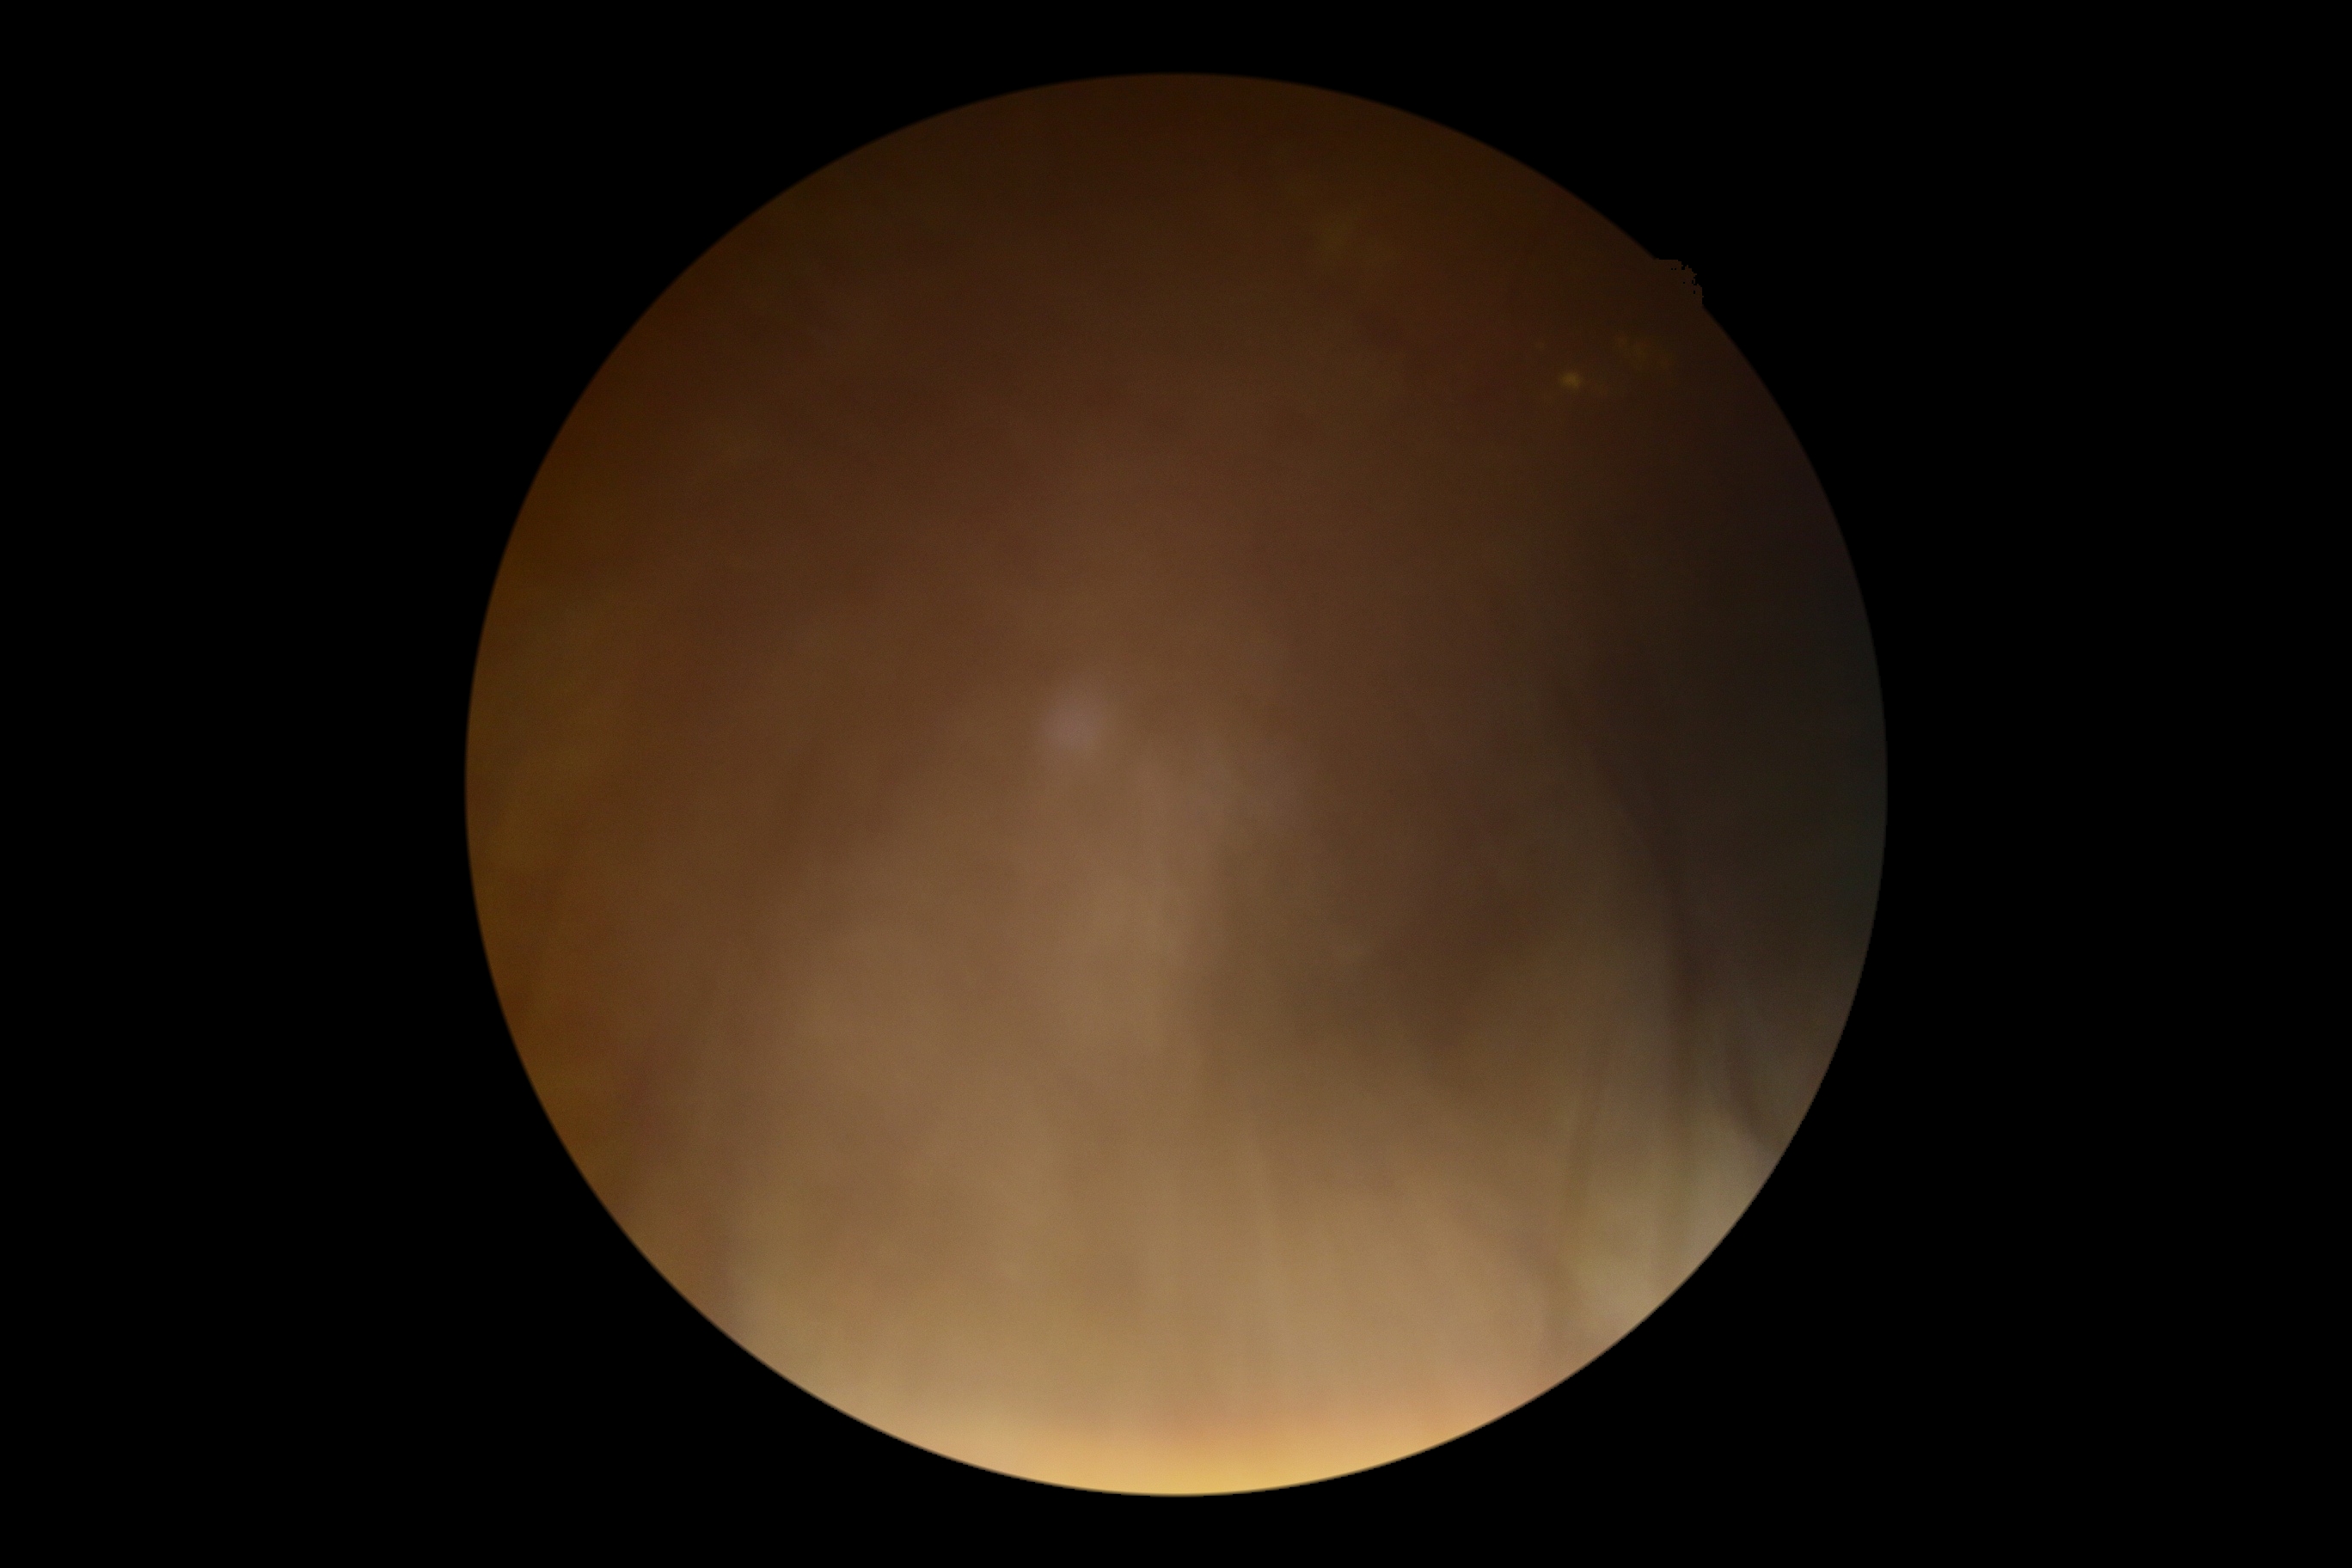 {
  "dr_grade": "ungradable"
}